Tabletop color fundus camera image · 1534 by 1534 pixels: 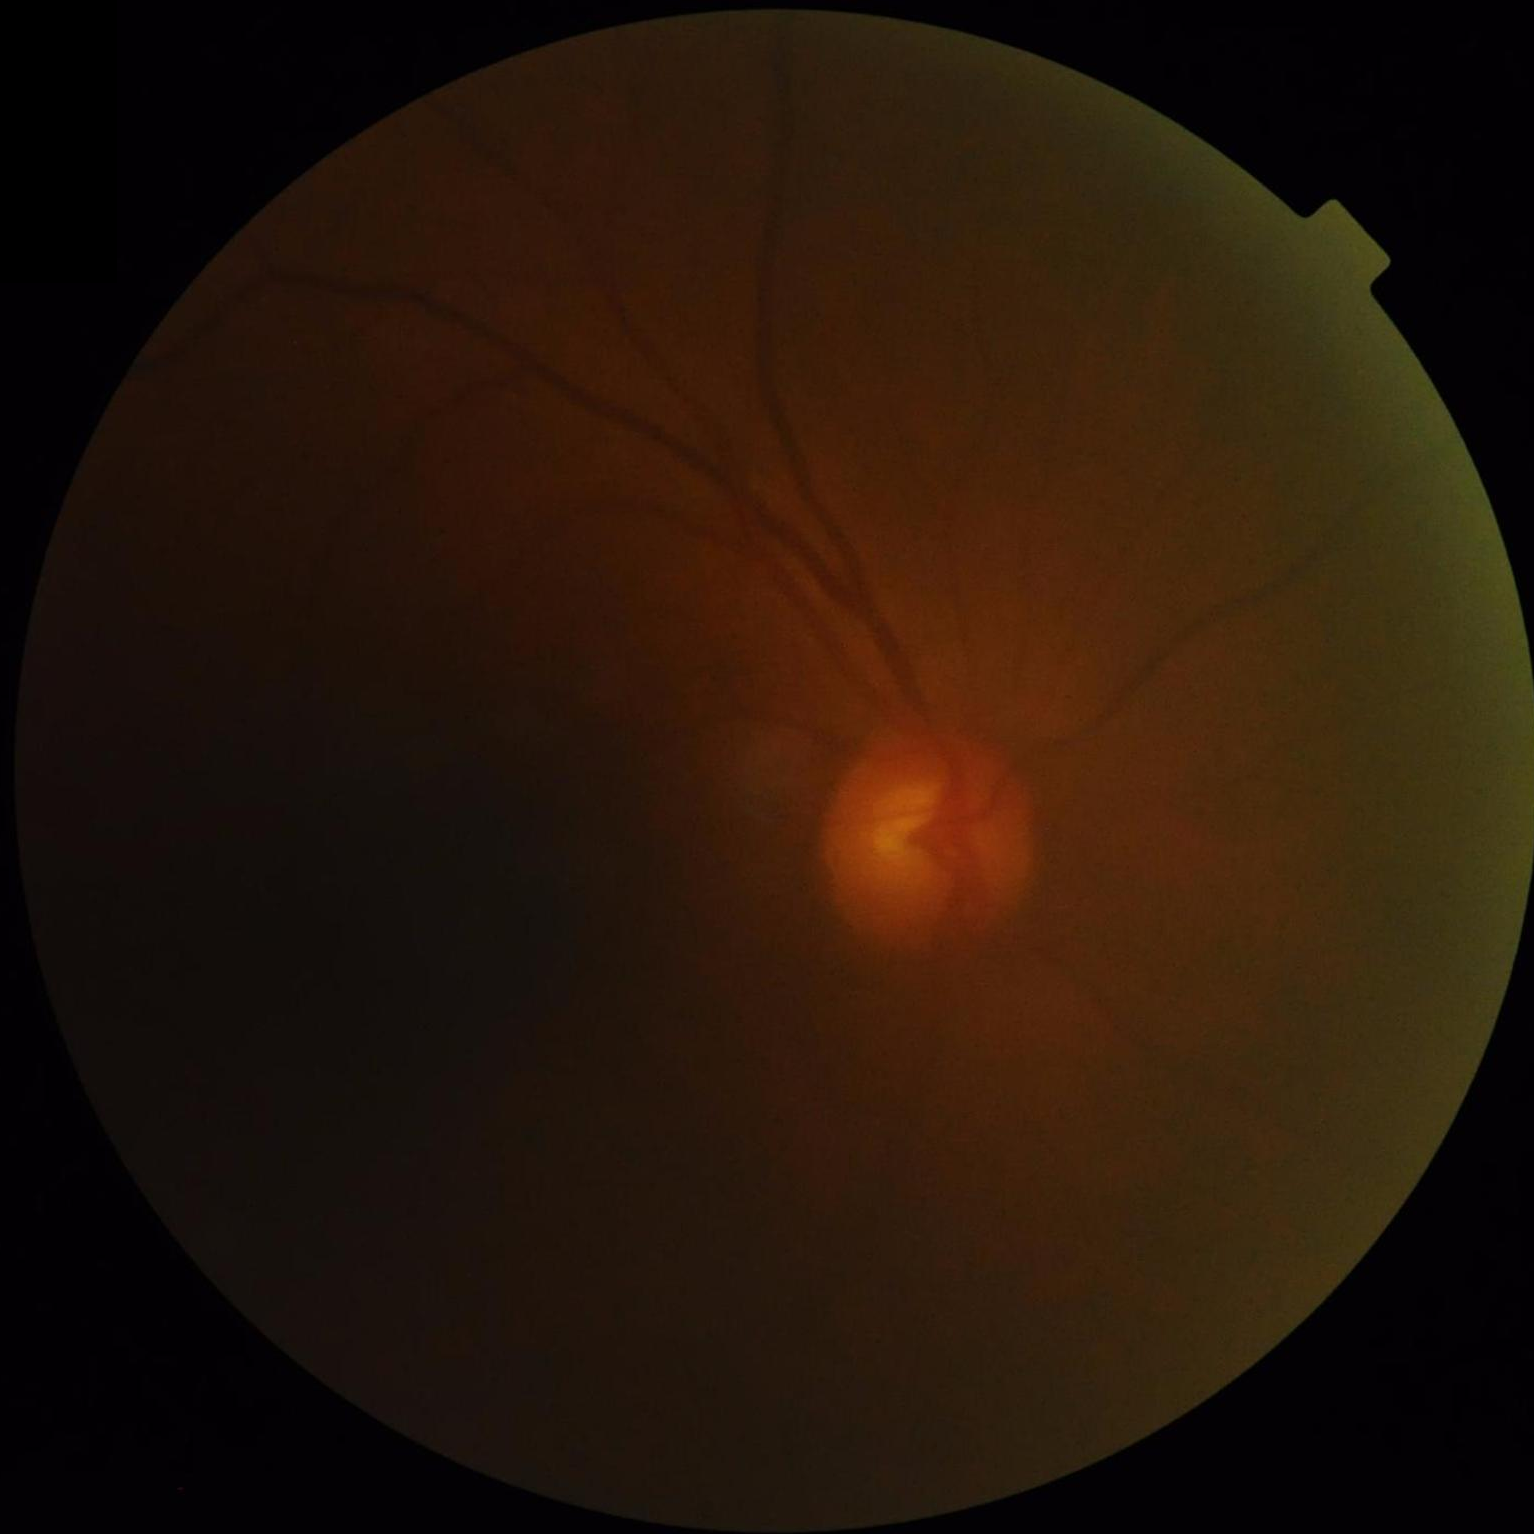 Vessels and details are hard to distinguish. Illumination and color are suboptimal. Overall quality is poor; the image is difficult to grade. Out of focus; structures are indistinct.